DR severity per modified Davis staging — 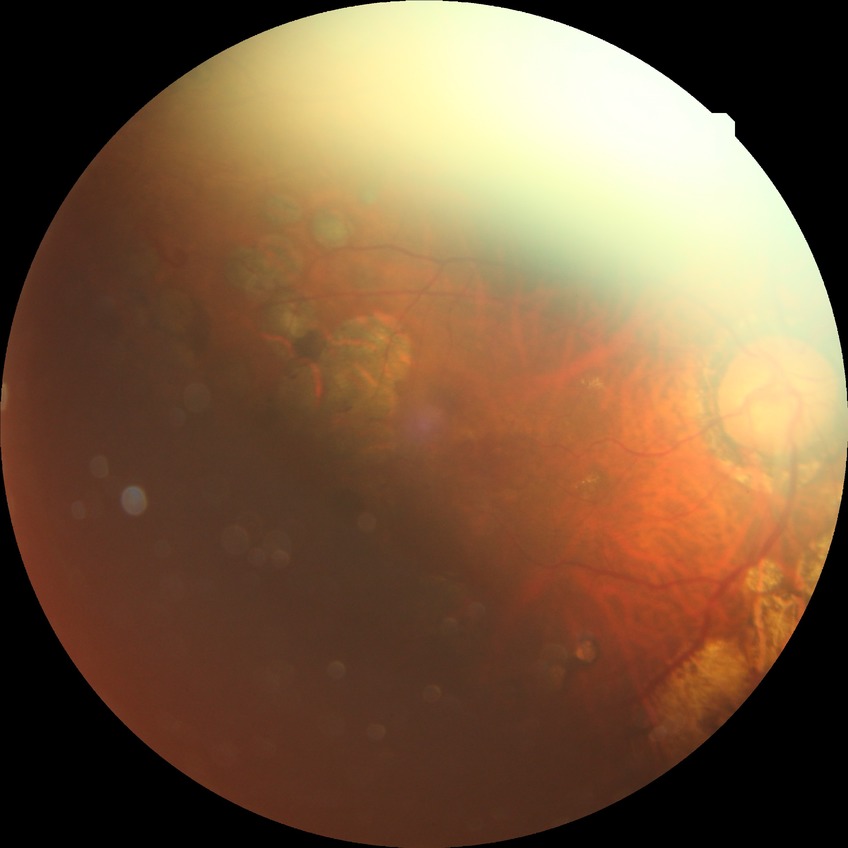

Diabetic retinopathy (DR): proliferative diabetic retinopathy (PDR).